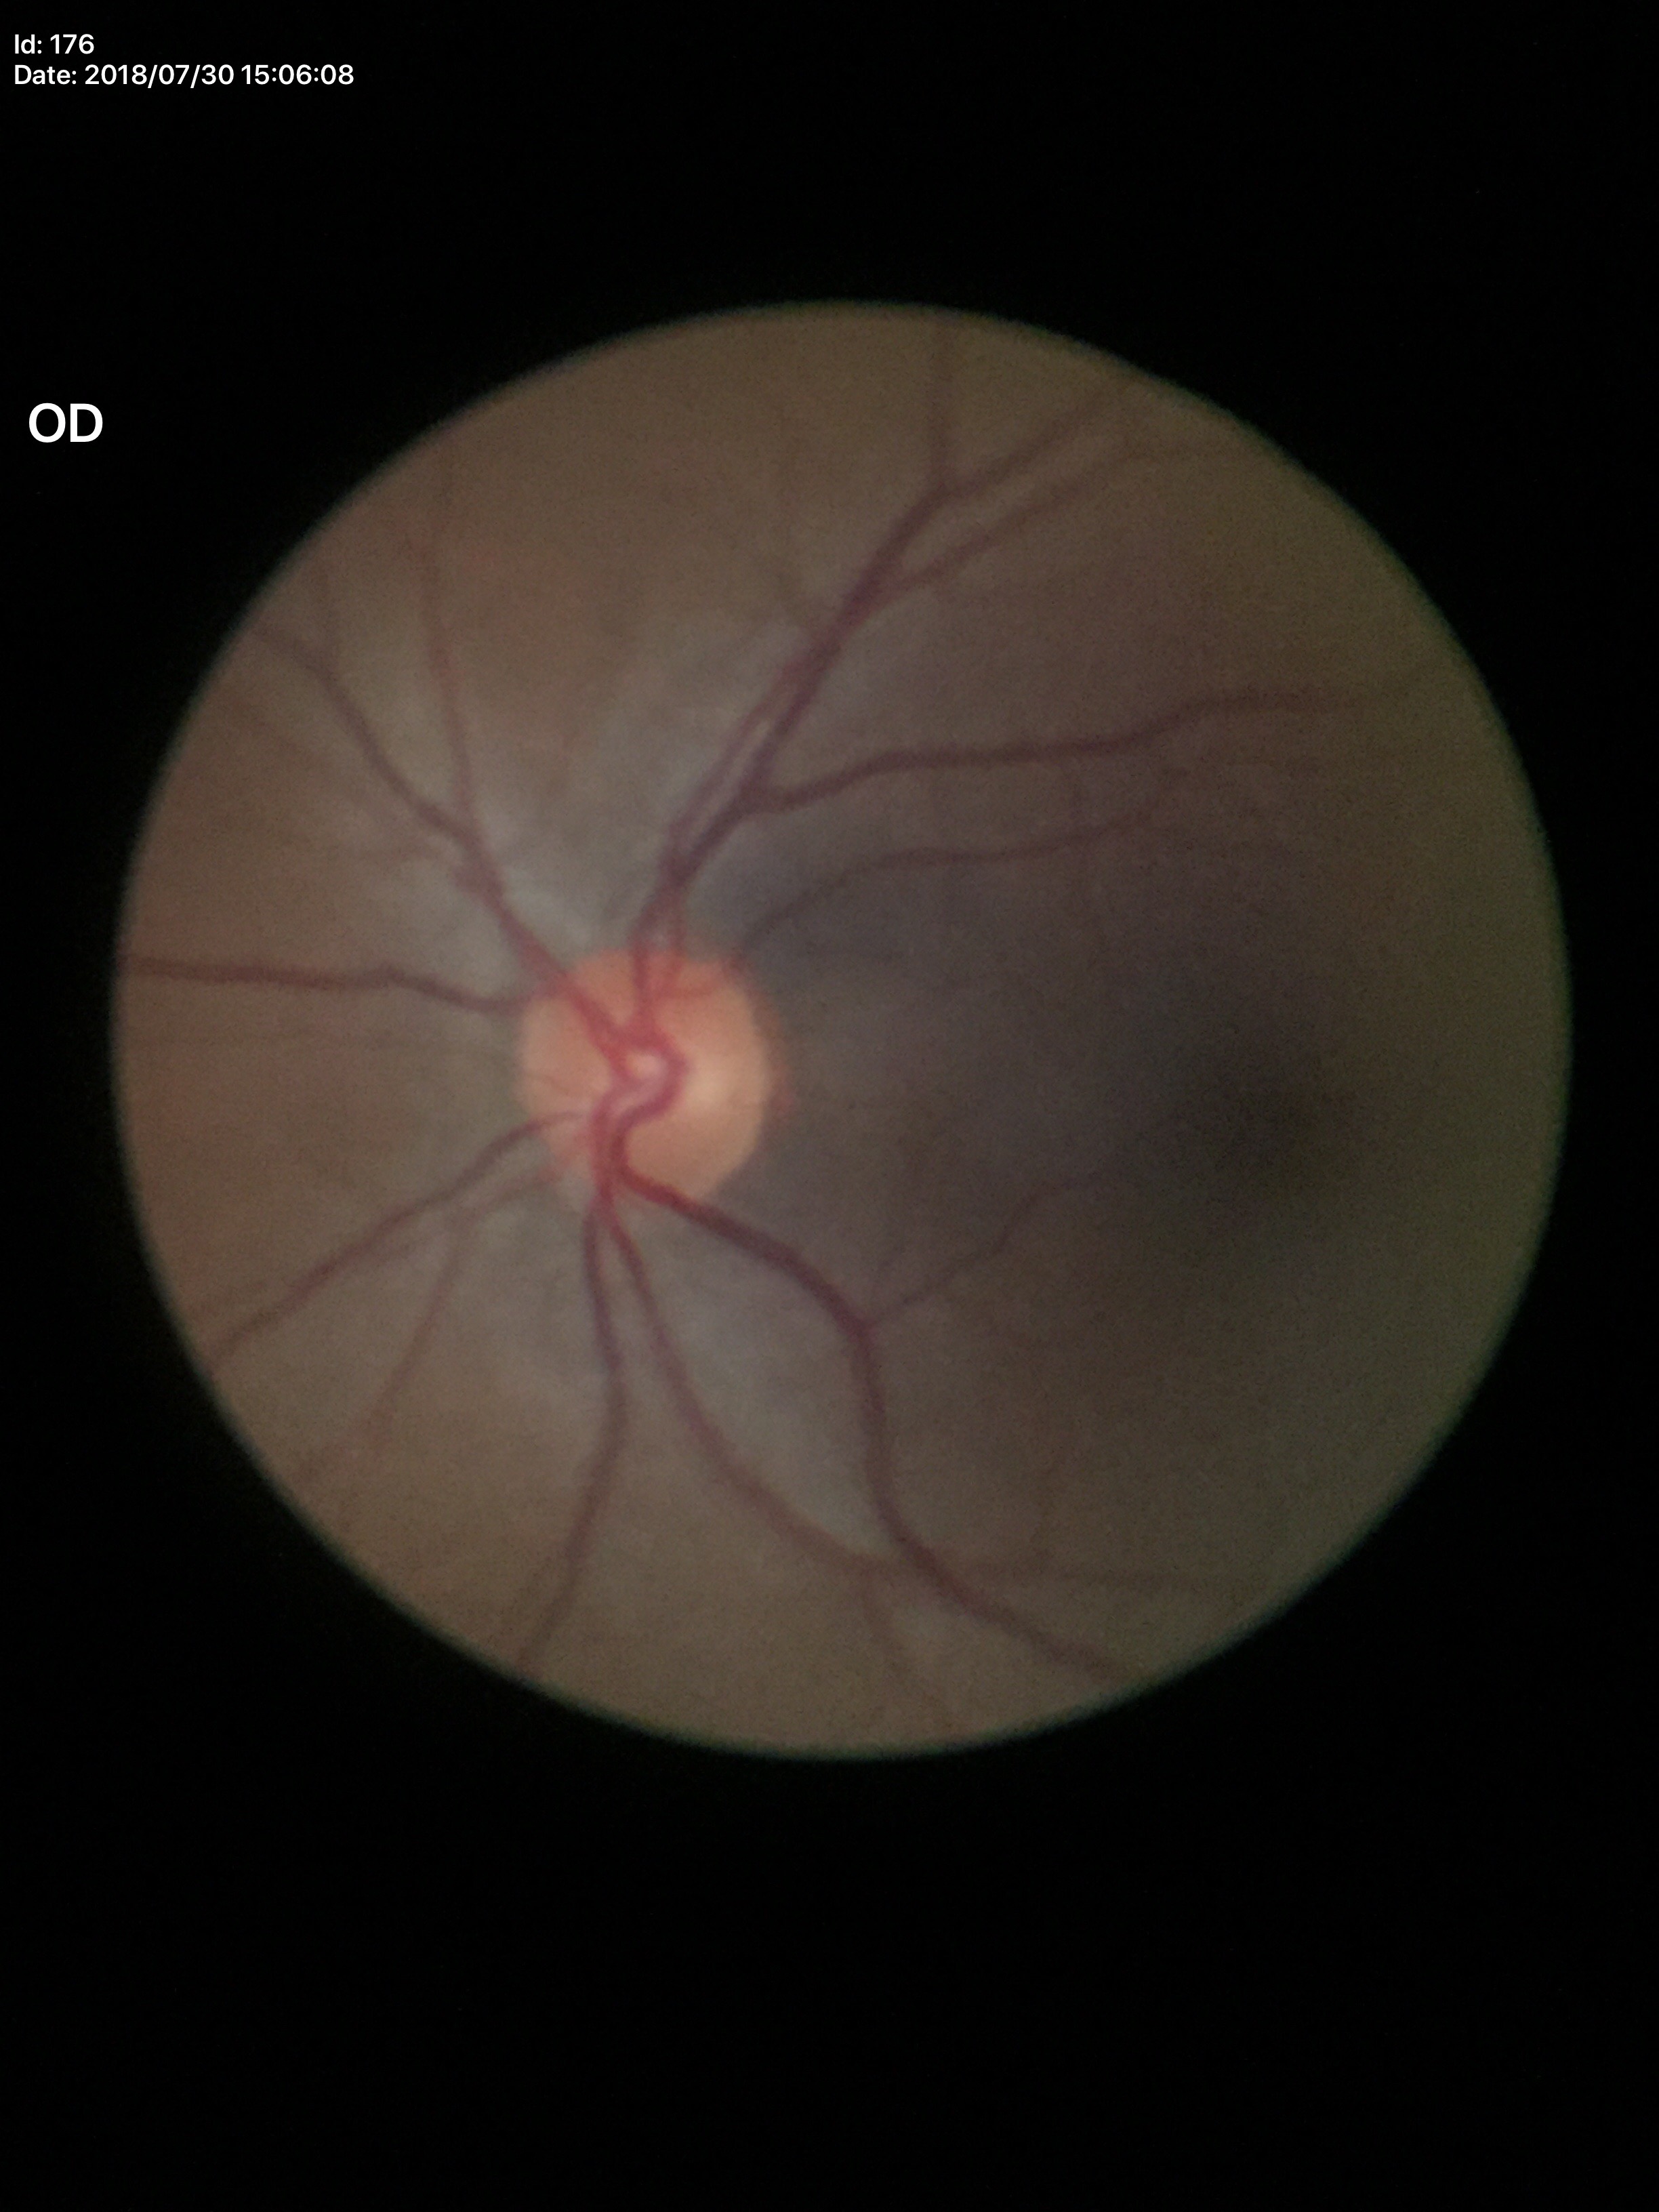

VCDR: 0.44 | Glaucoma decision: not suspect.